45-degree field of view
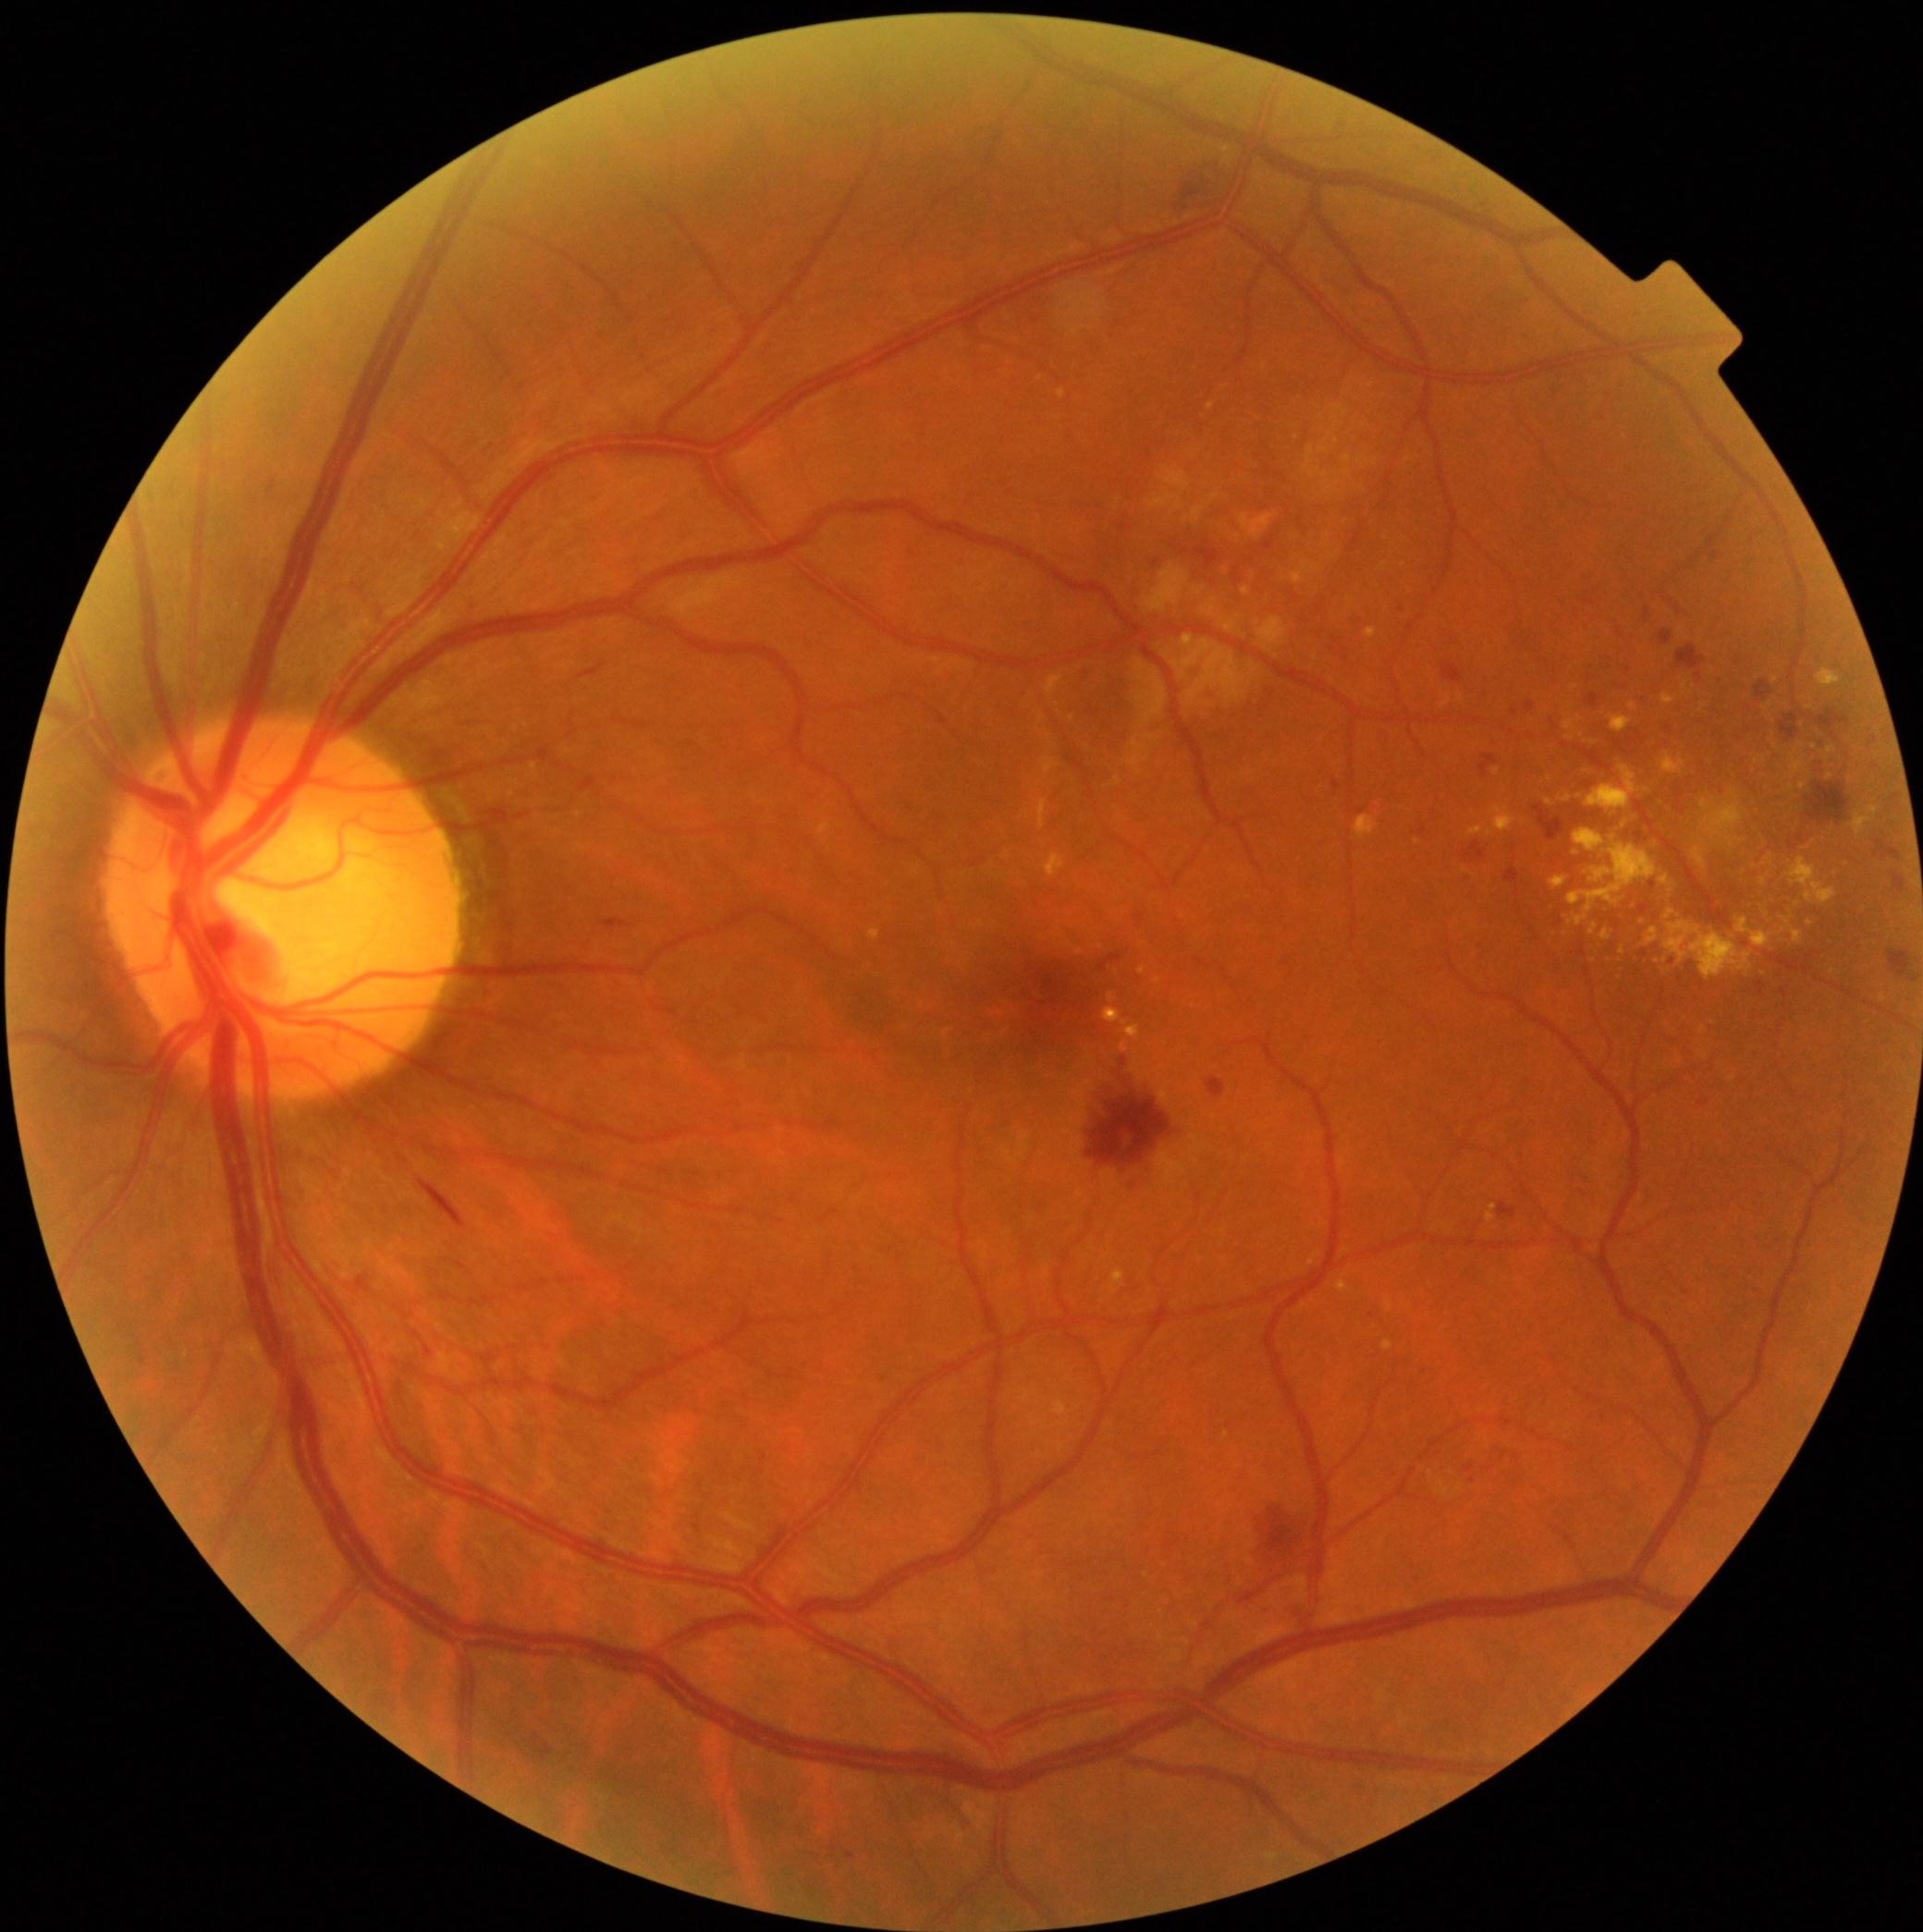

Diabetic retinopathy grade: 2 (moderate NPDR)
Lesions identified (partial list):
hard exudates (partial): <bbox>869, 930, 880, 942</bbox>; <bbox>1545, 799, 1555, 807</bbox>; <bbox>1039, 801, 1047, 829</bbox>; <bbox>1623, 820, 1630, 829</bbox>; <bbox>1682, 683, 1688, 691</bbox>; <bbox>1609, 715, 1634, 734</bbox>; <bbox>1356, 816, 1378, 840</bbox>; <bbox>1601, 930, 1611, 942</bbox>; <bbox>1596, 1213, 1609, 1225</bbox>; <bbox>1769, 855, 1774, 864</bbox>; <bbox>1791, 751, 1806, 775</bbox>; <bbox>1789, 859, 1836, 904</bbox>; <bbox>1568, 829, 1658, 926</bbox>; <bbox>1488, 1205, 1497, 1225</bbox>
Small hard exudates approximately at 1832/751; 1783/931; 1810/923; 1798/904; 1595/743; 1646/790
hemorrhages (partial): <bbox>1894, 875, 1907, 895</bbox>; <bbox>1178, 167, 1238, 211</bbox>; <bbox>1778, 715, 1800, 741</bbox>; <bbox>1586, 694, 1599, 709</bbox>; <bbox>1099, 957, 1121, 972</bbox>; <bbox>1420, 827, 1427, 837</bbox>; <bbox>1534, 807, 1564, 842</bbox>; <bbox>1086, 1082, 1170, 1183</bbox>; <bbox>488, 809, 510, 825</bbox>; <bbox>1196, 550, 1221, 570</bbox>; <bbox>605, 919, 631, 930</bbox>; <bbox>582, 664, 606, 679</bbox>; <bbox>532, 1732, 554, 1763</bbox>; <bbox>1806, 782, 1849, 825</bbox>
Small hemorrhages approximately at 1518/895
microaneurysms (partial): <bbox>1121, 1059, 1127, 1067</bbox>; <bbox>1585, 968, 1590, 977</bbox>; <bbox>1526, 703, 1534, 713</bbox>; <bbox>1208, 687, 1216, 696</bbox>; <bbox>1120, 523, 1127, 532</bbox>; <bbox>1643, 951, 1648, 959</bbox>; <bbox>1262, 541, 1276, 552</bbox>; <bbox>1639, 906, 1648, 915</bbox>; <bbox>1472, 718, 1480, 724</bbox>
Small microaneurysms approximately at 1155/563; 1401/611; 1631/741; 1583/954; 1663/1001; 1671/963; 834/1850
soft exudates (partial): <bbox>1145, 565, 1189, 612</bbox>; <bbox>1343, 470, 1353, 477</bbox>; <bbox>1324, 535, 1331, 543</bbox>; <bbox>1152, 490, 1183, 510</bbox>; <bbox>1356, 456, 1369, 468</bbox>; <bbox>1172, 636, 1253, 703</bbox>; <bbox>1322, 473, 1335, 497</bbox>; <bbox>1242, 516, 1274, 539</bbox>; <bbox>1202, 600, 1216, 618</bbox>; <bbox>1320, 415, 1324, 424</bbox>
Small soft exudates approximately at 1298/439